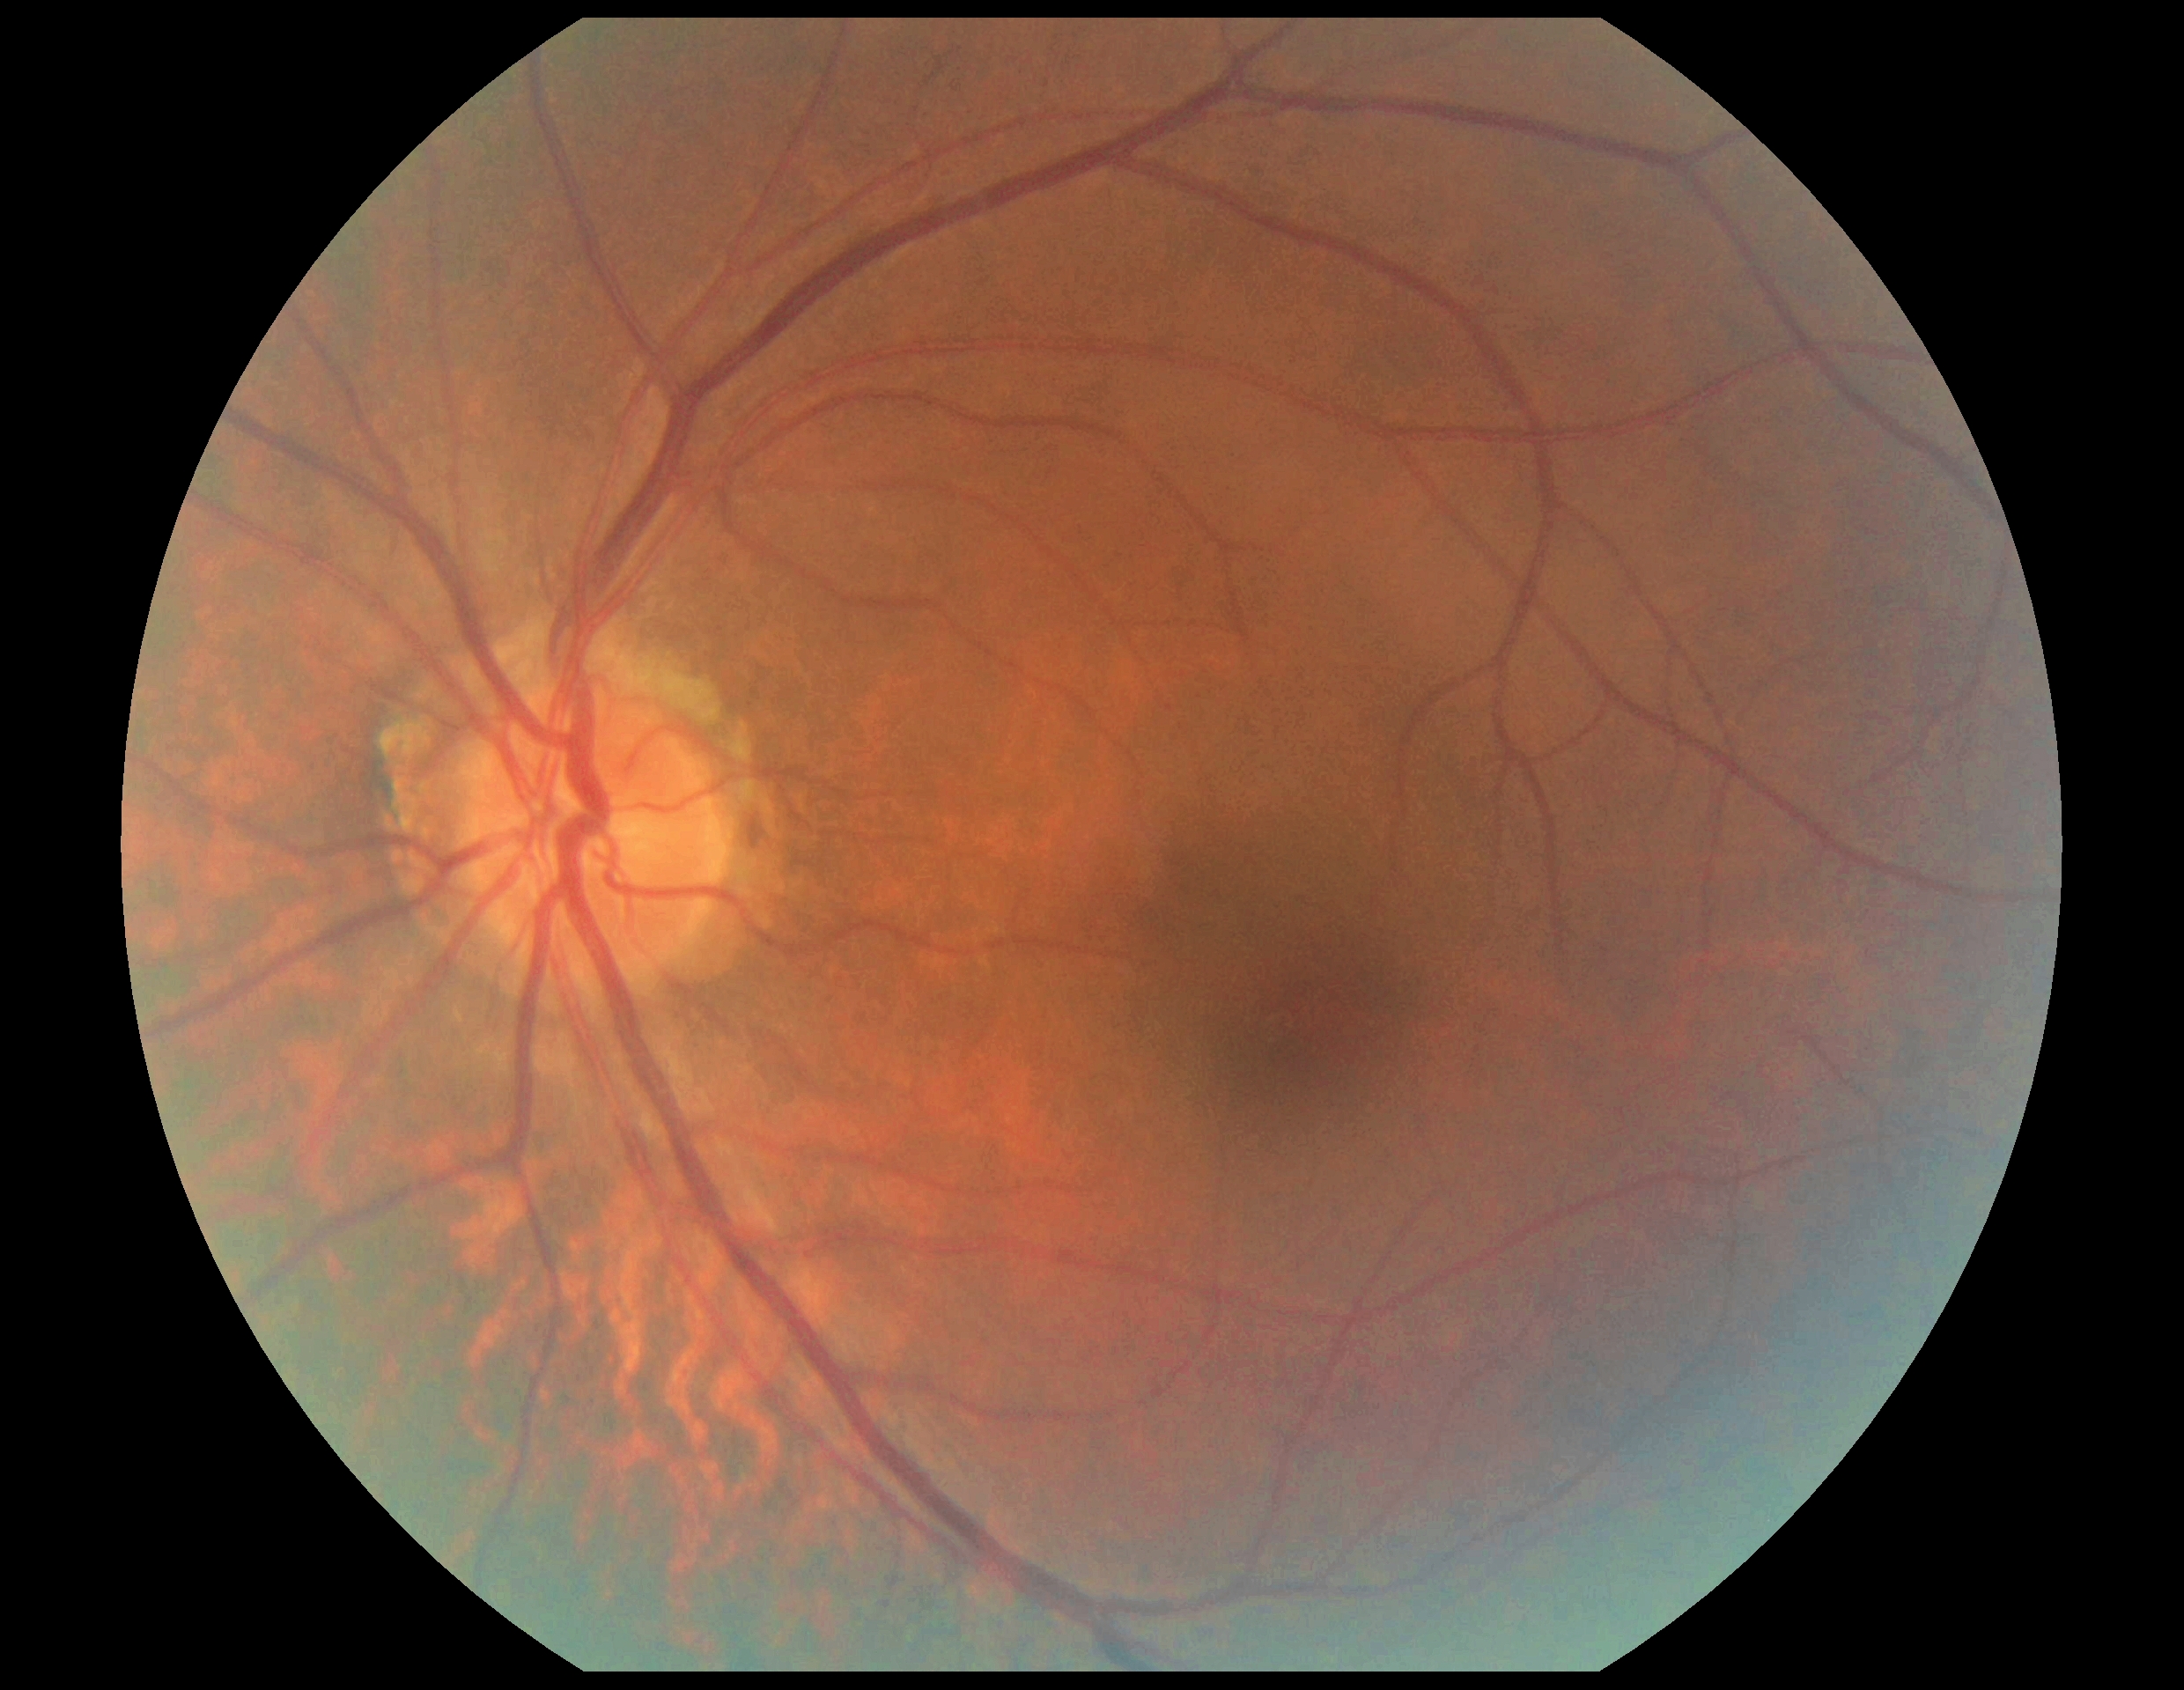
• DR severity — 0